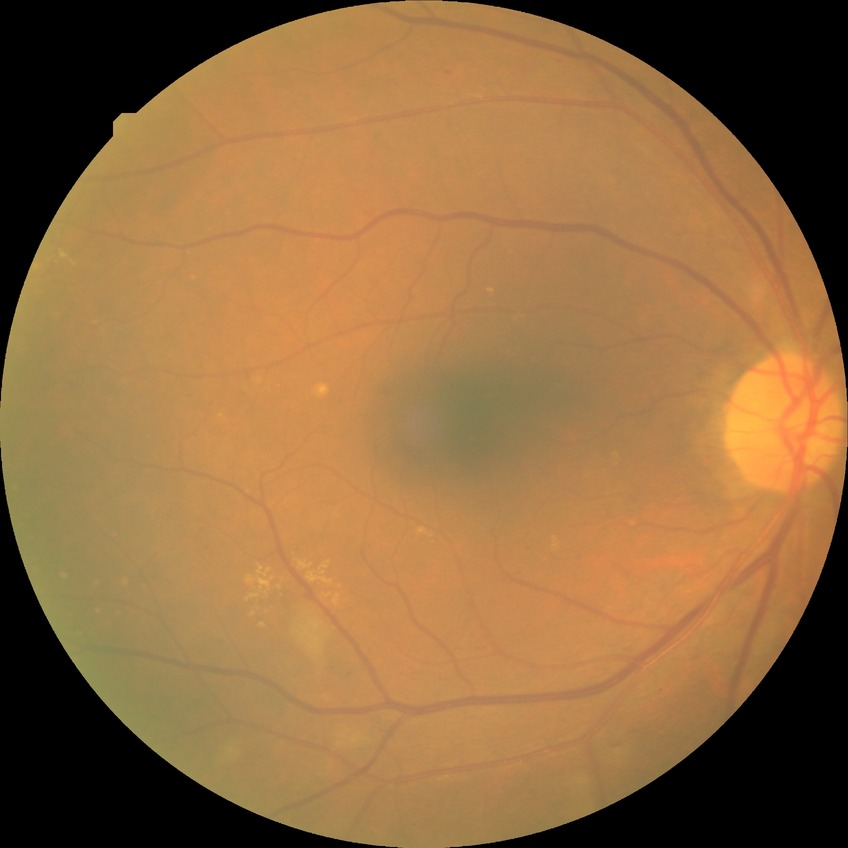
Annotations:
* DR class — non-proliferative diabetic retinopathy
* DR stage — SDR